848x848px. No pharmacologic dilation:
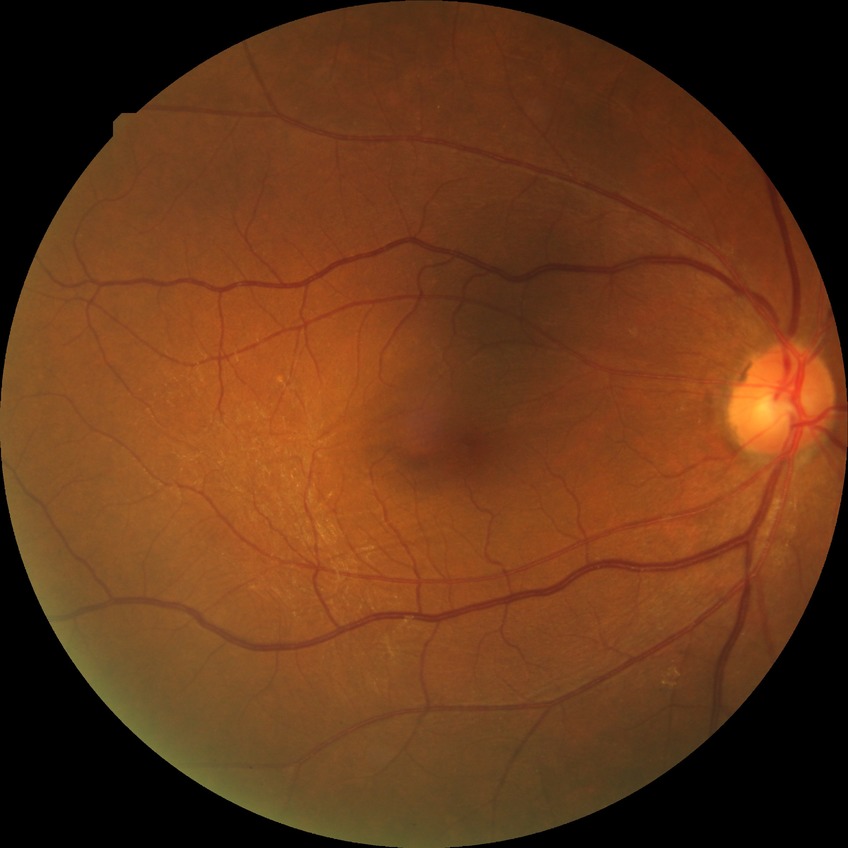 diabetic retinopathy grade = no diabetic retinopathy.